Nonmydriatic fundus photograph; NIDEK AFC-230; fundus photo; 848x848px; 45° FOV: 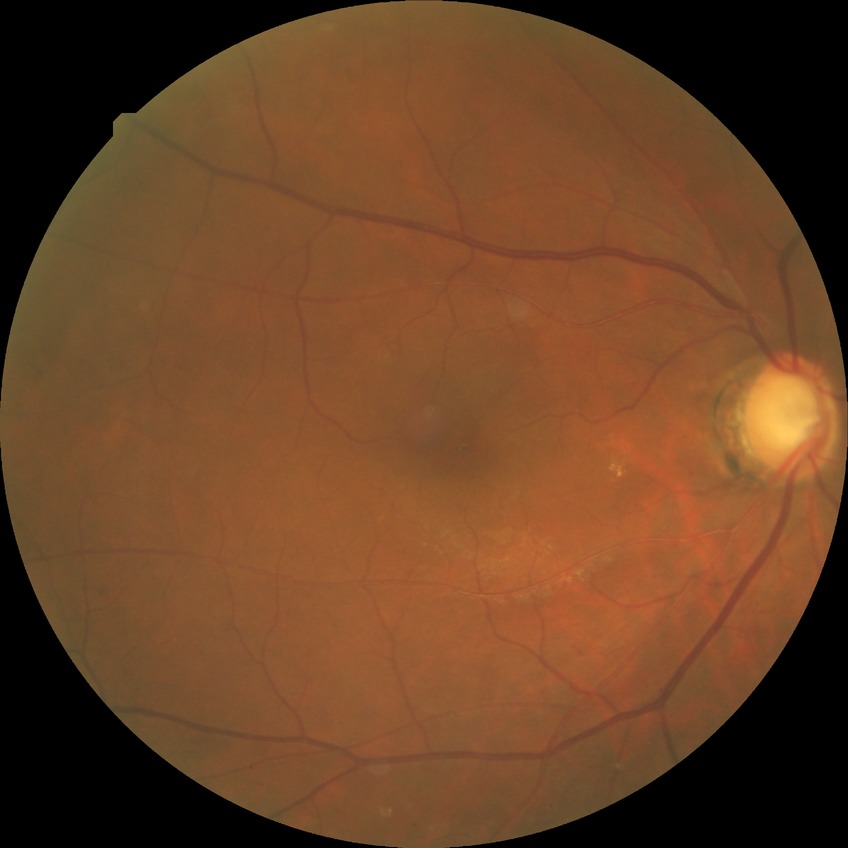
Retinopathy grade: simple diabetic retinopathy.
The retinopathy is classified as non-proliferative diabetic retinopathy.